Color fundus image
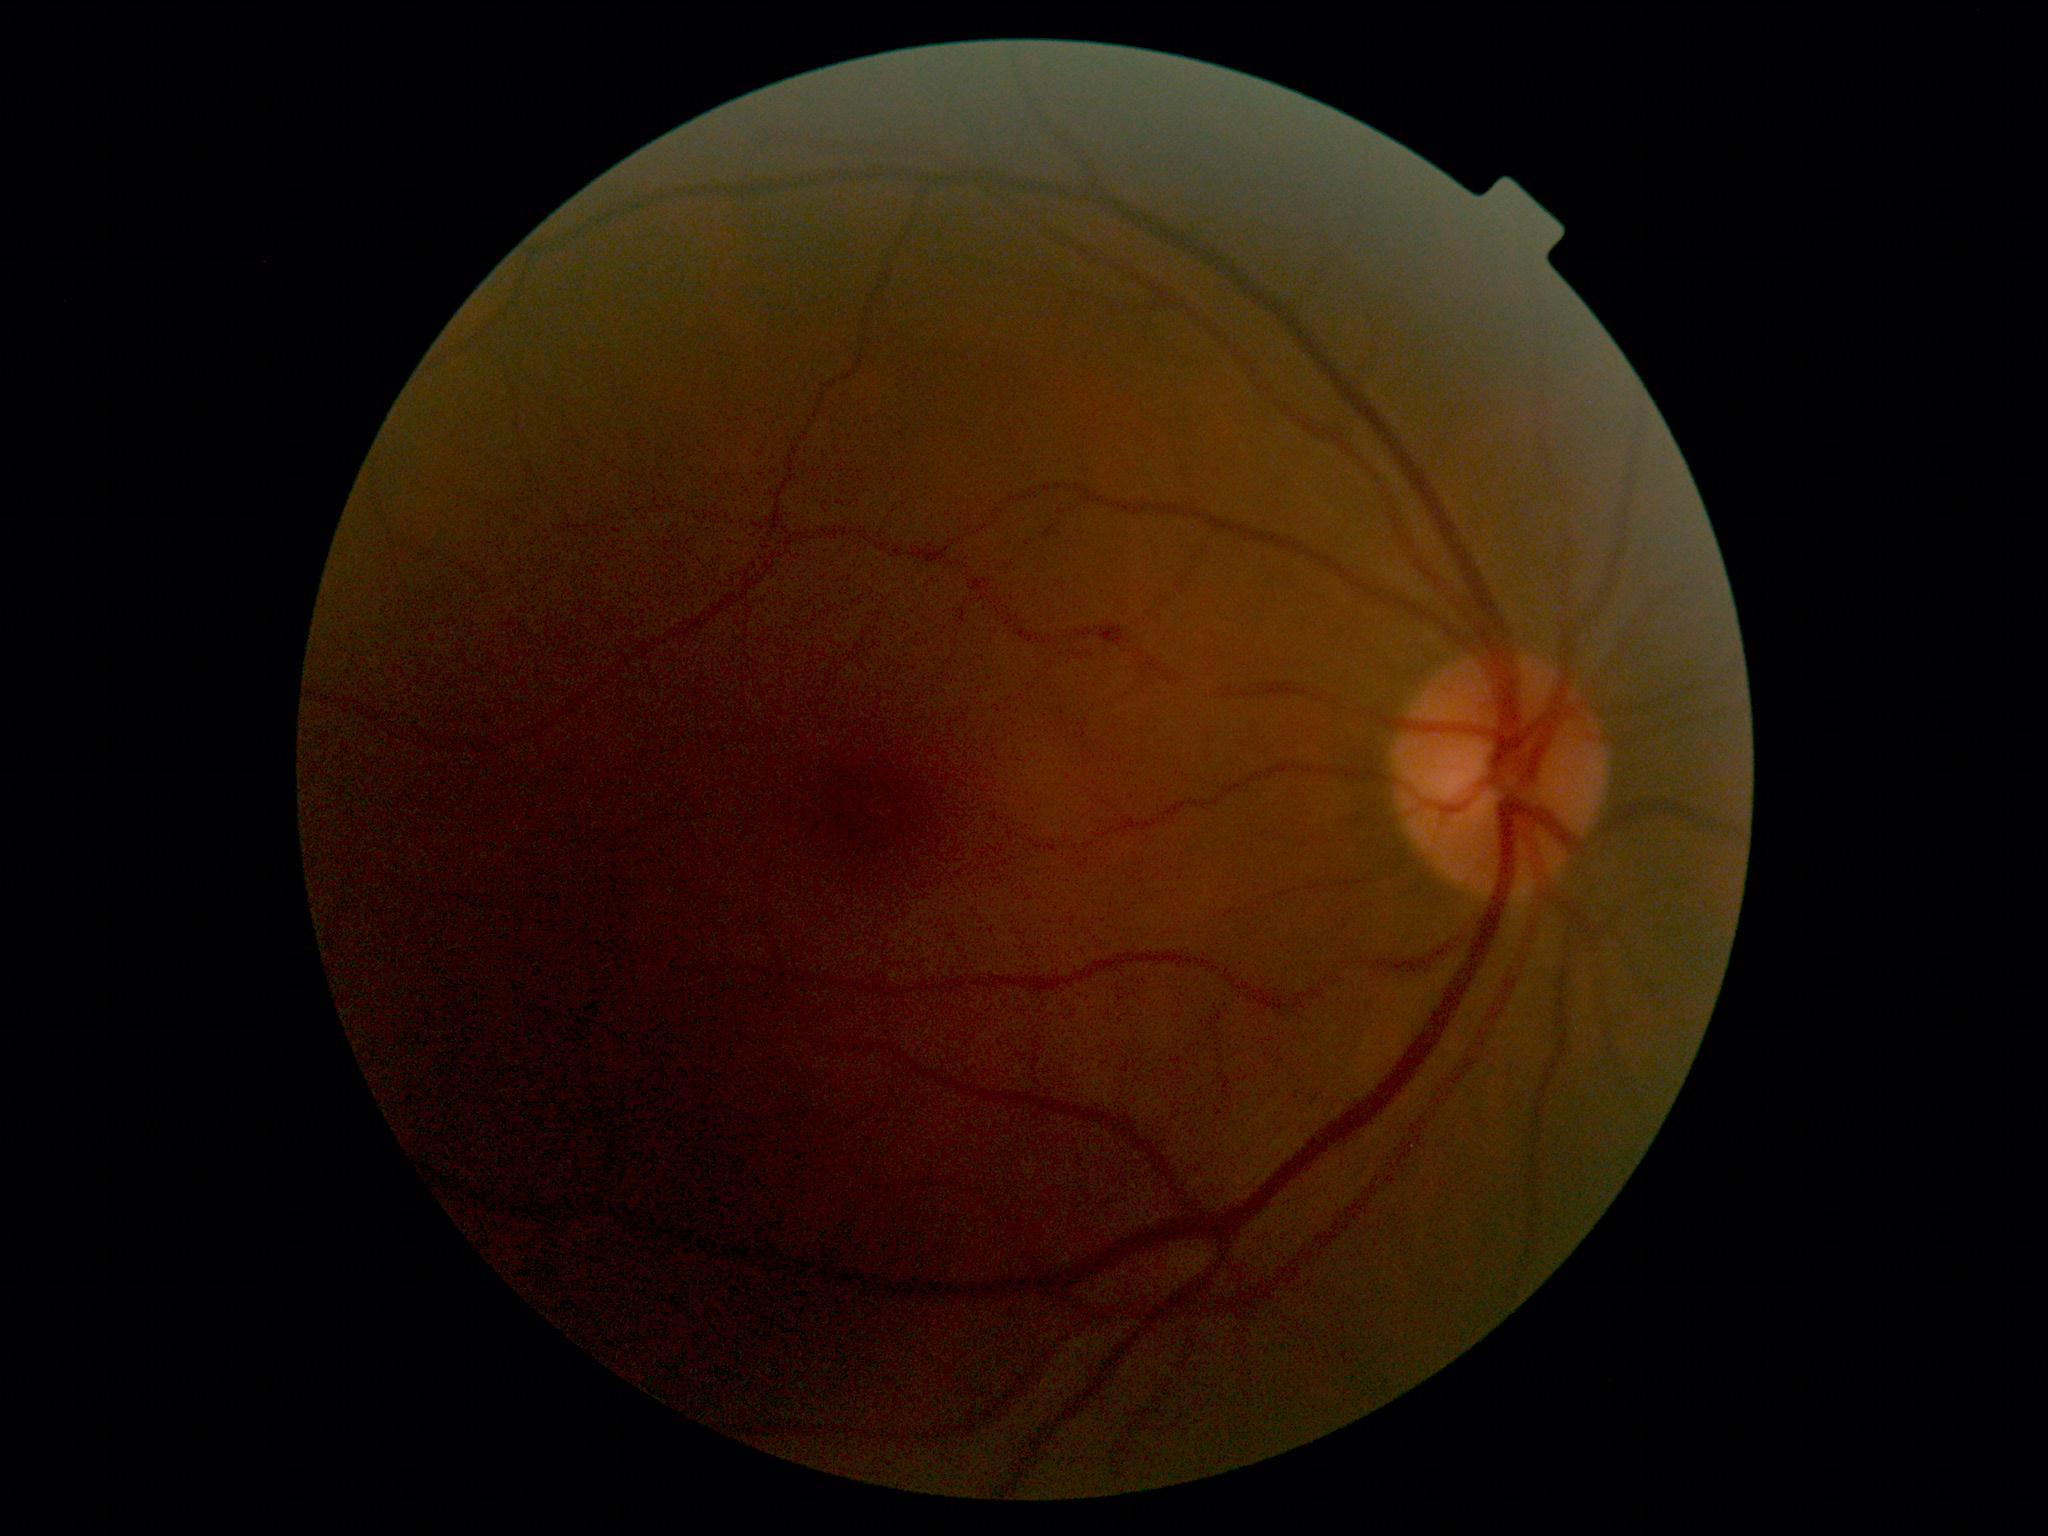
DR = 0/4 — no visible signs of diabetic retinopathy
DR impression = no signs of DR